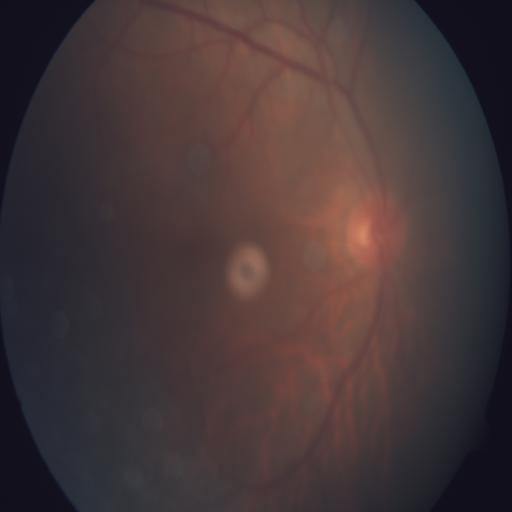 Showing tessellation.